Image size 1659x2212
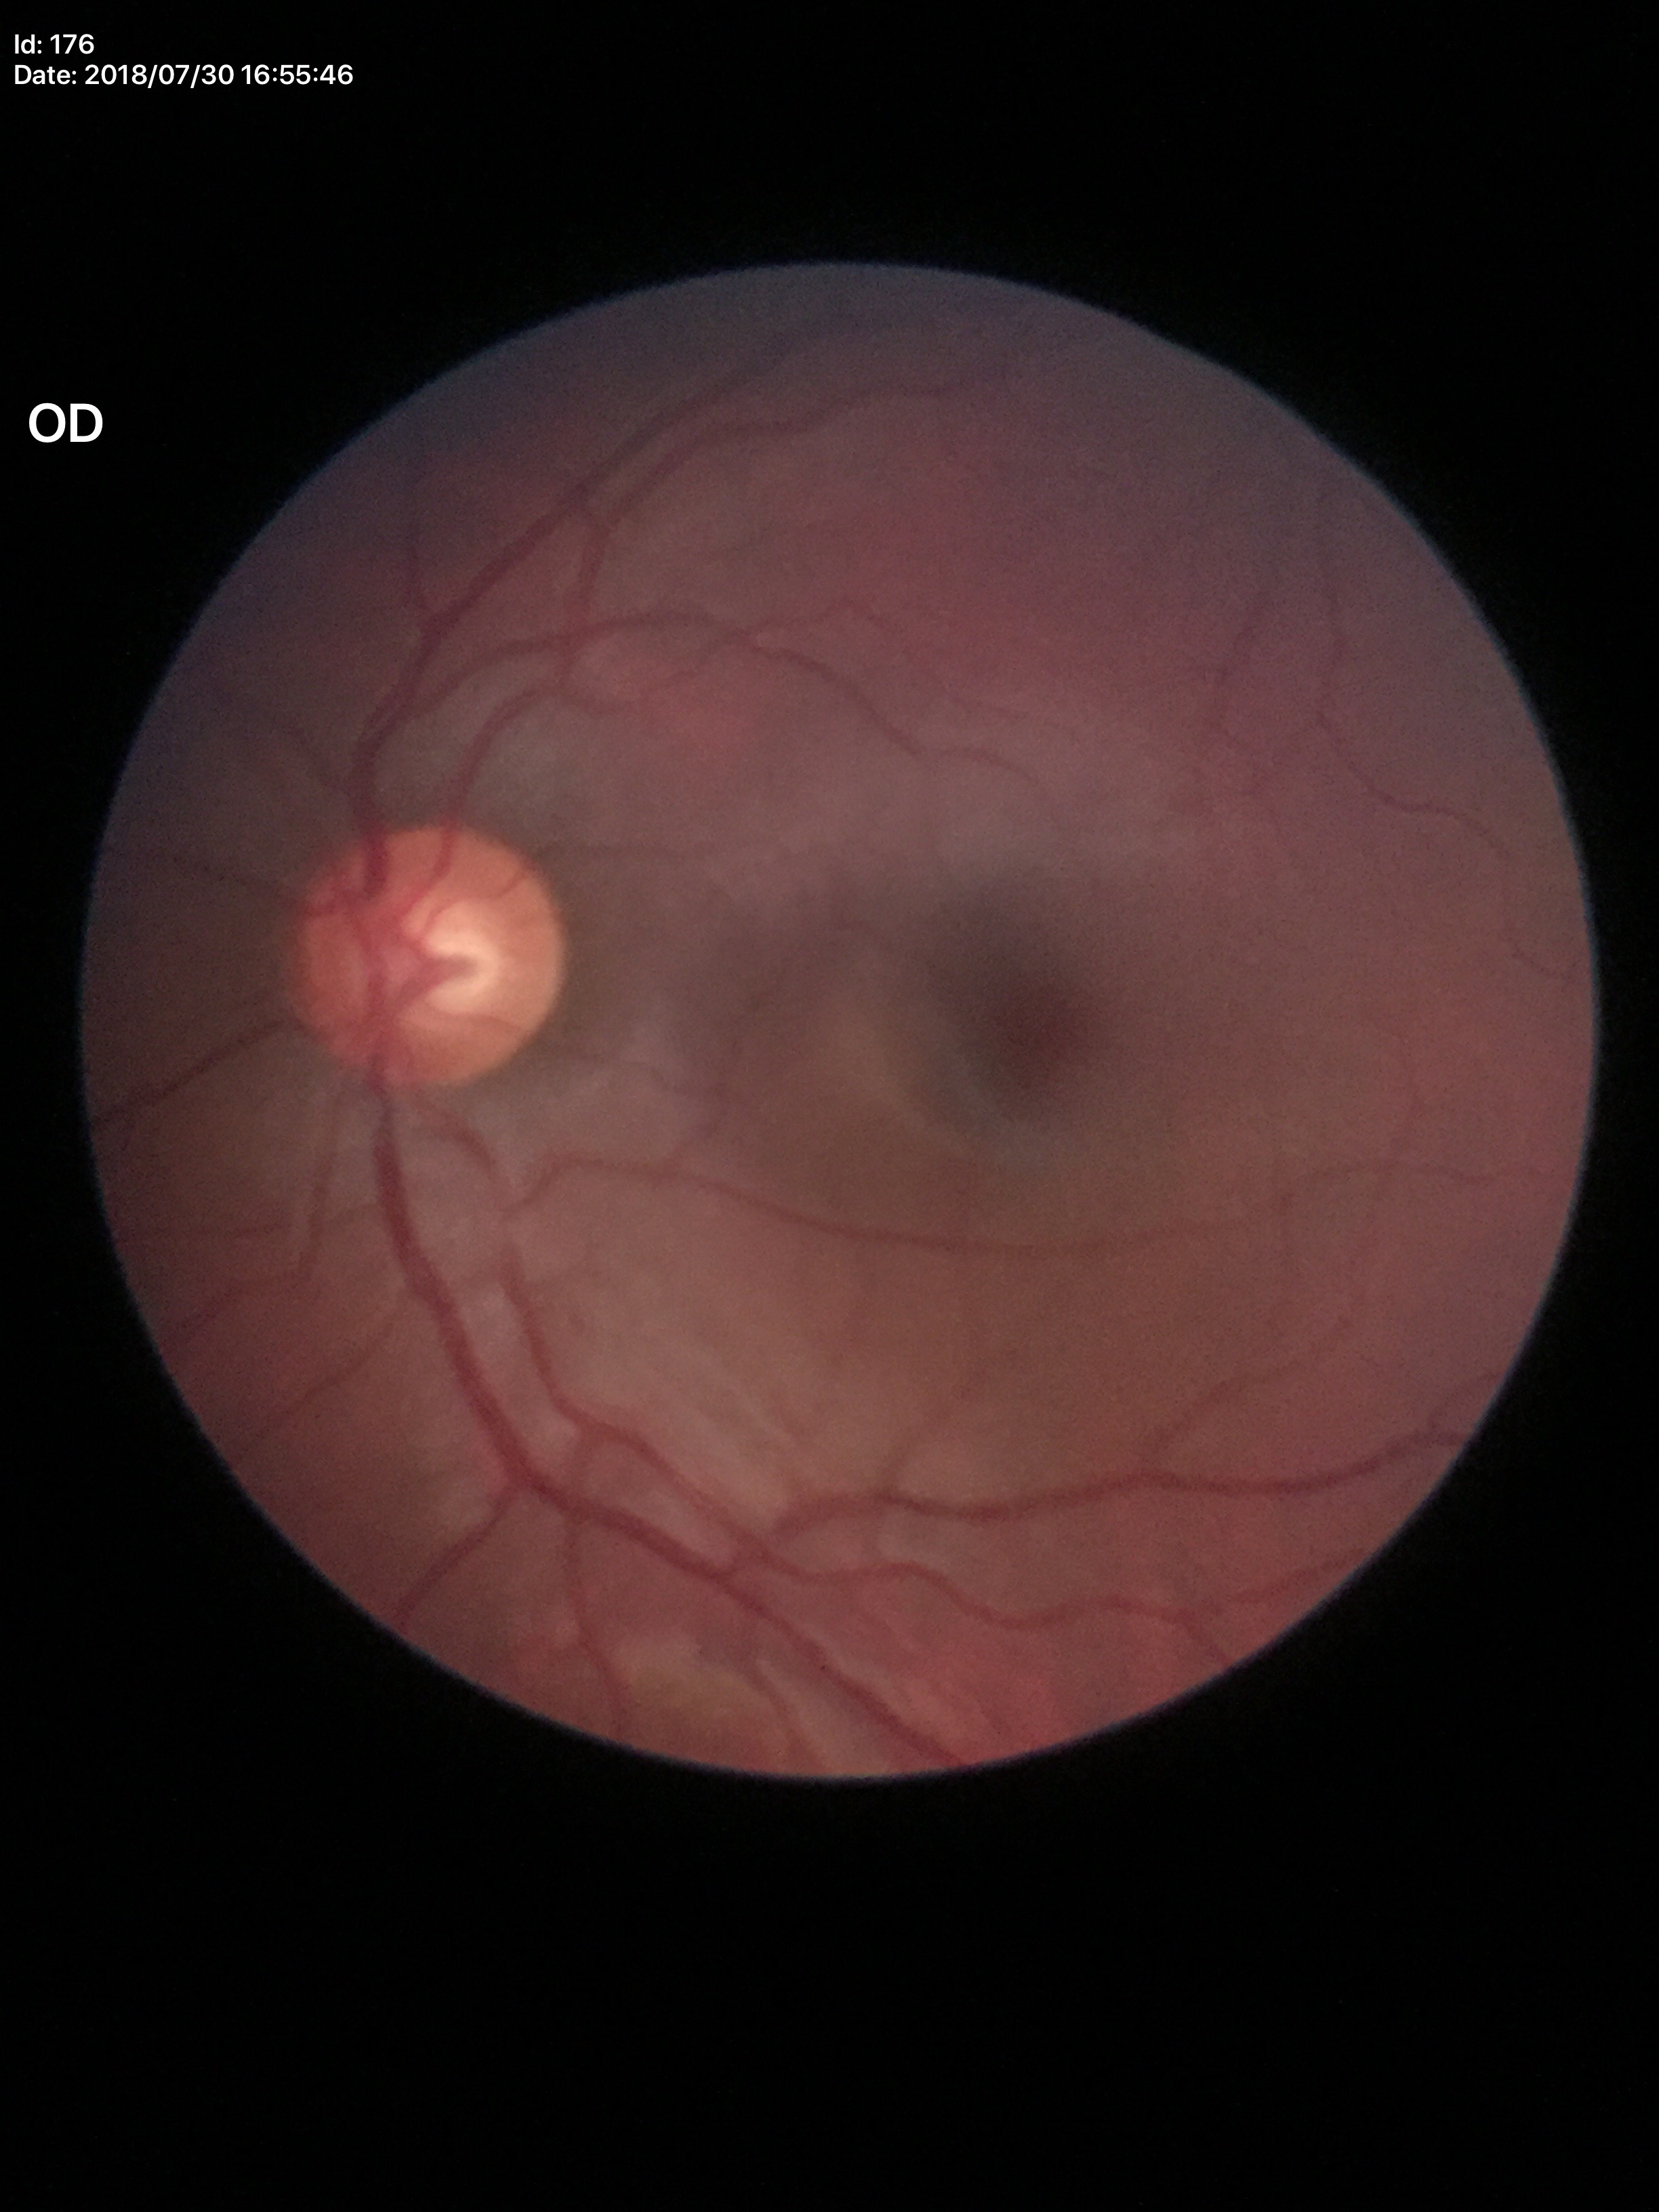

vertical CDR (VCDR)=0.58 | Glaucoma impression=not suspect